Infant wide-field fundus photograph — 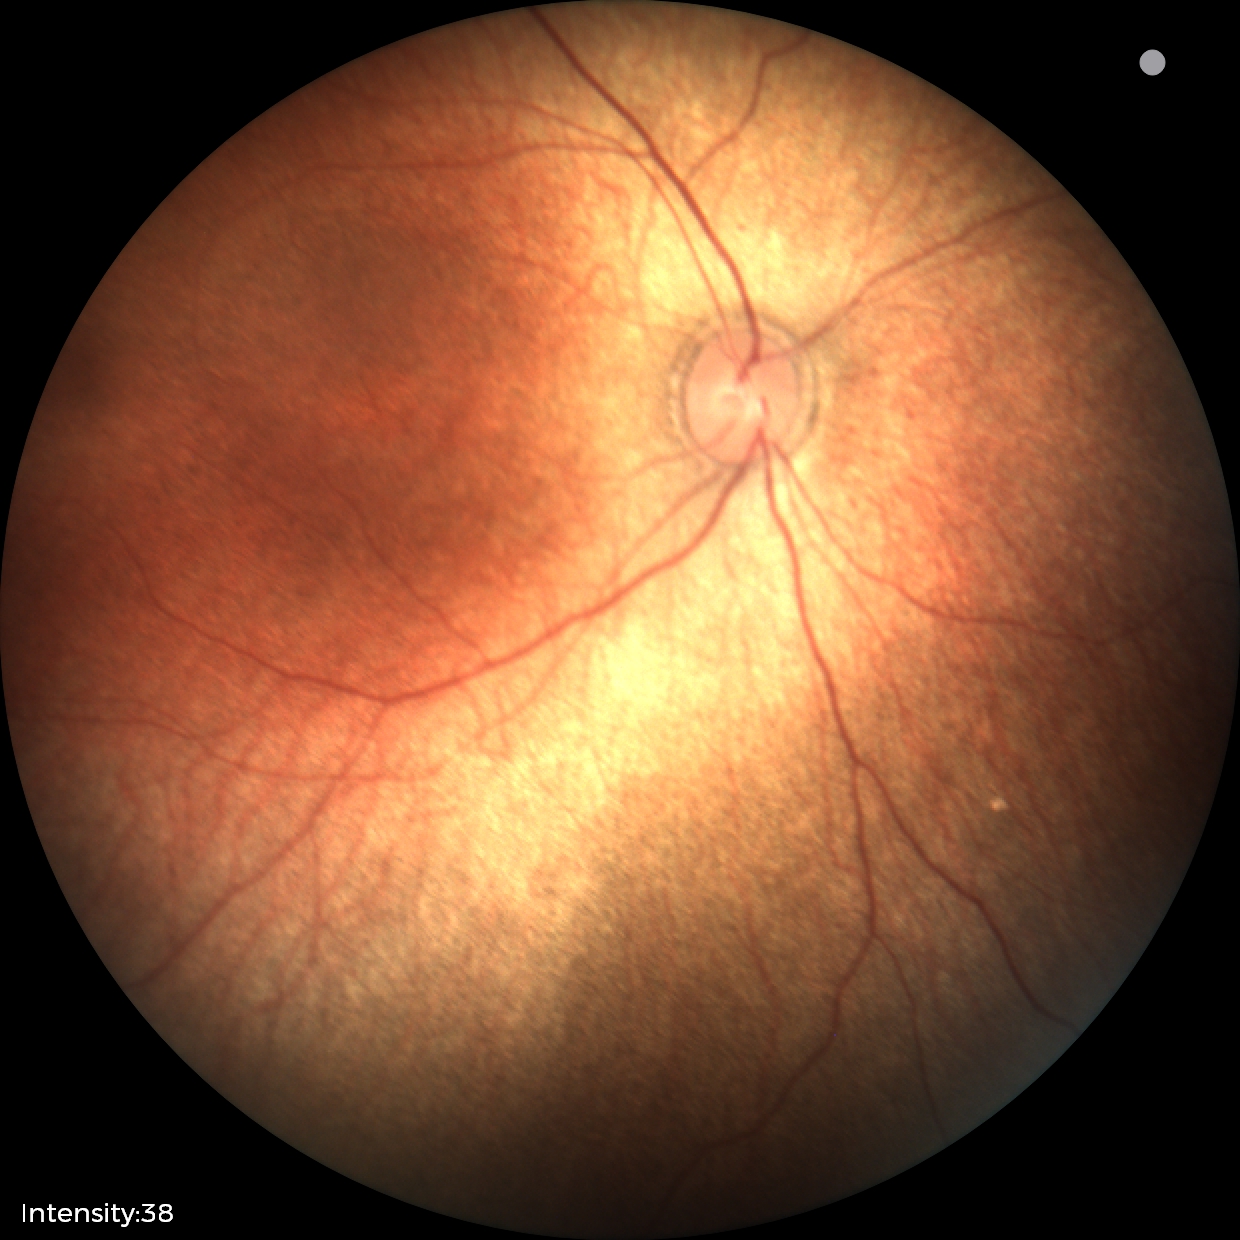 Screening: normal retinal appearance.